Fundus photo taken with a portable handheld camera
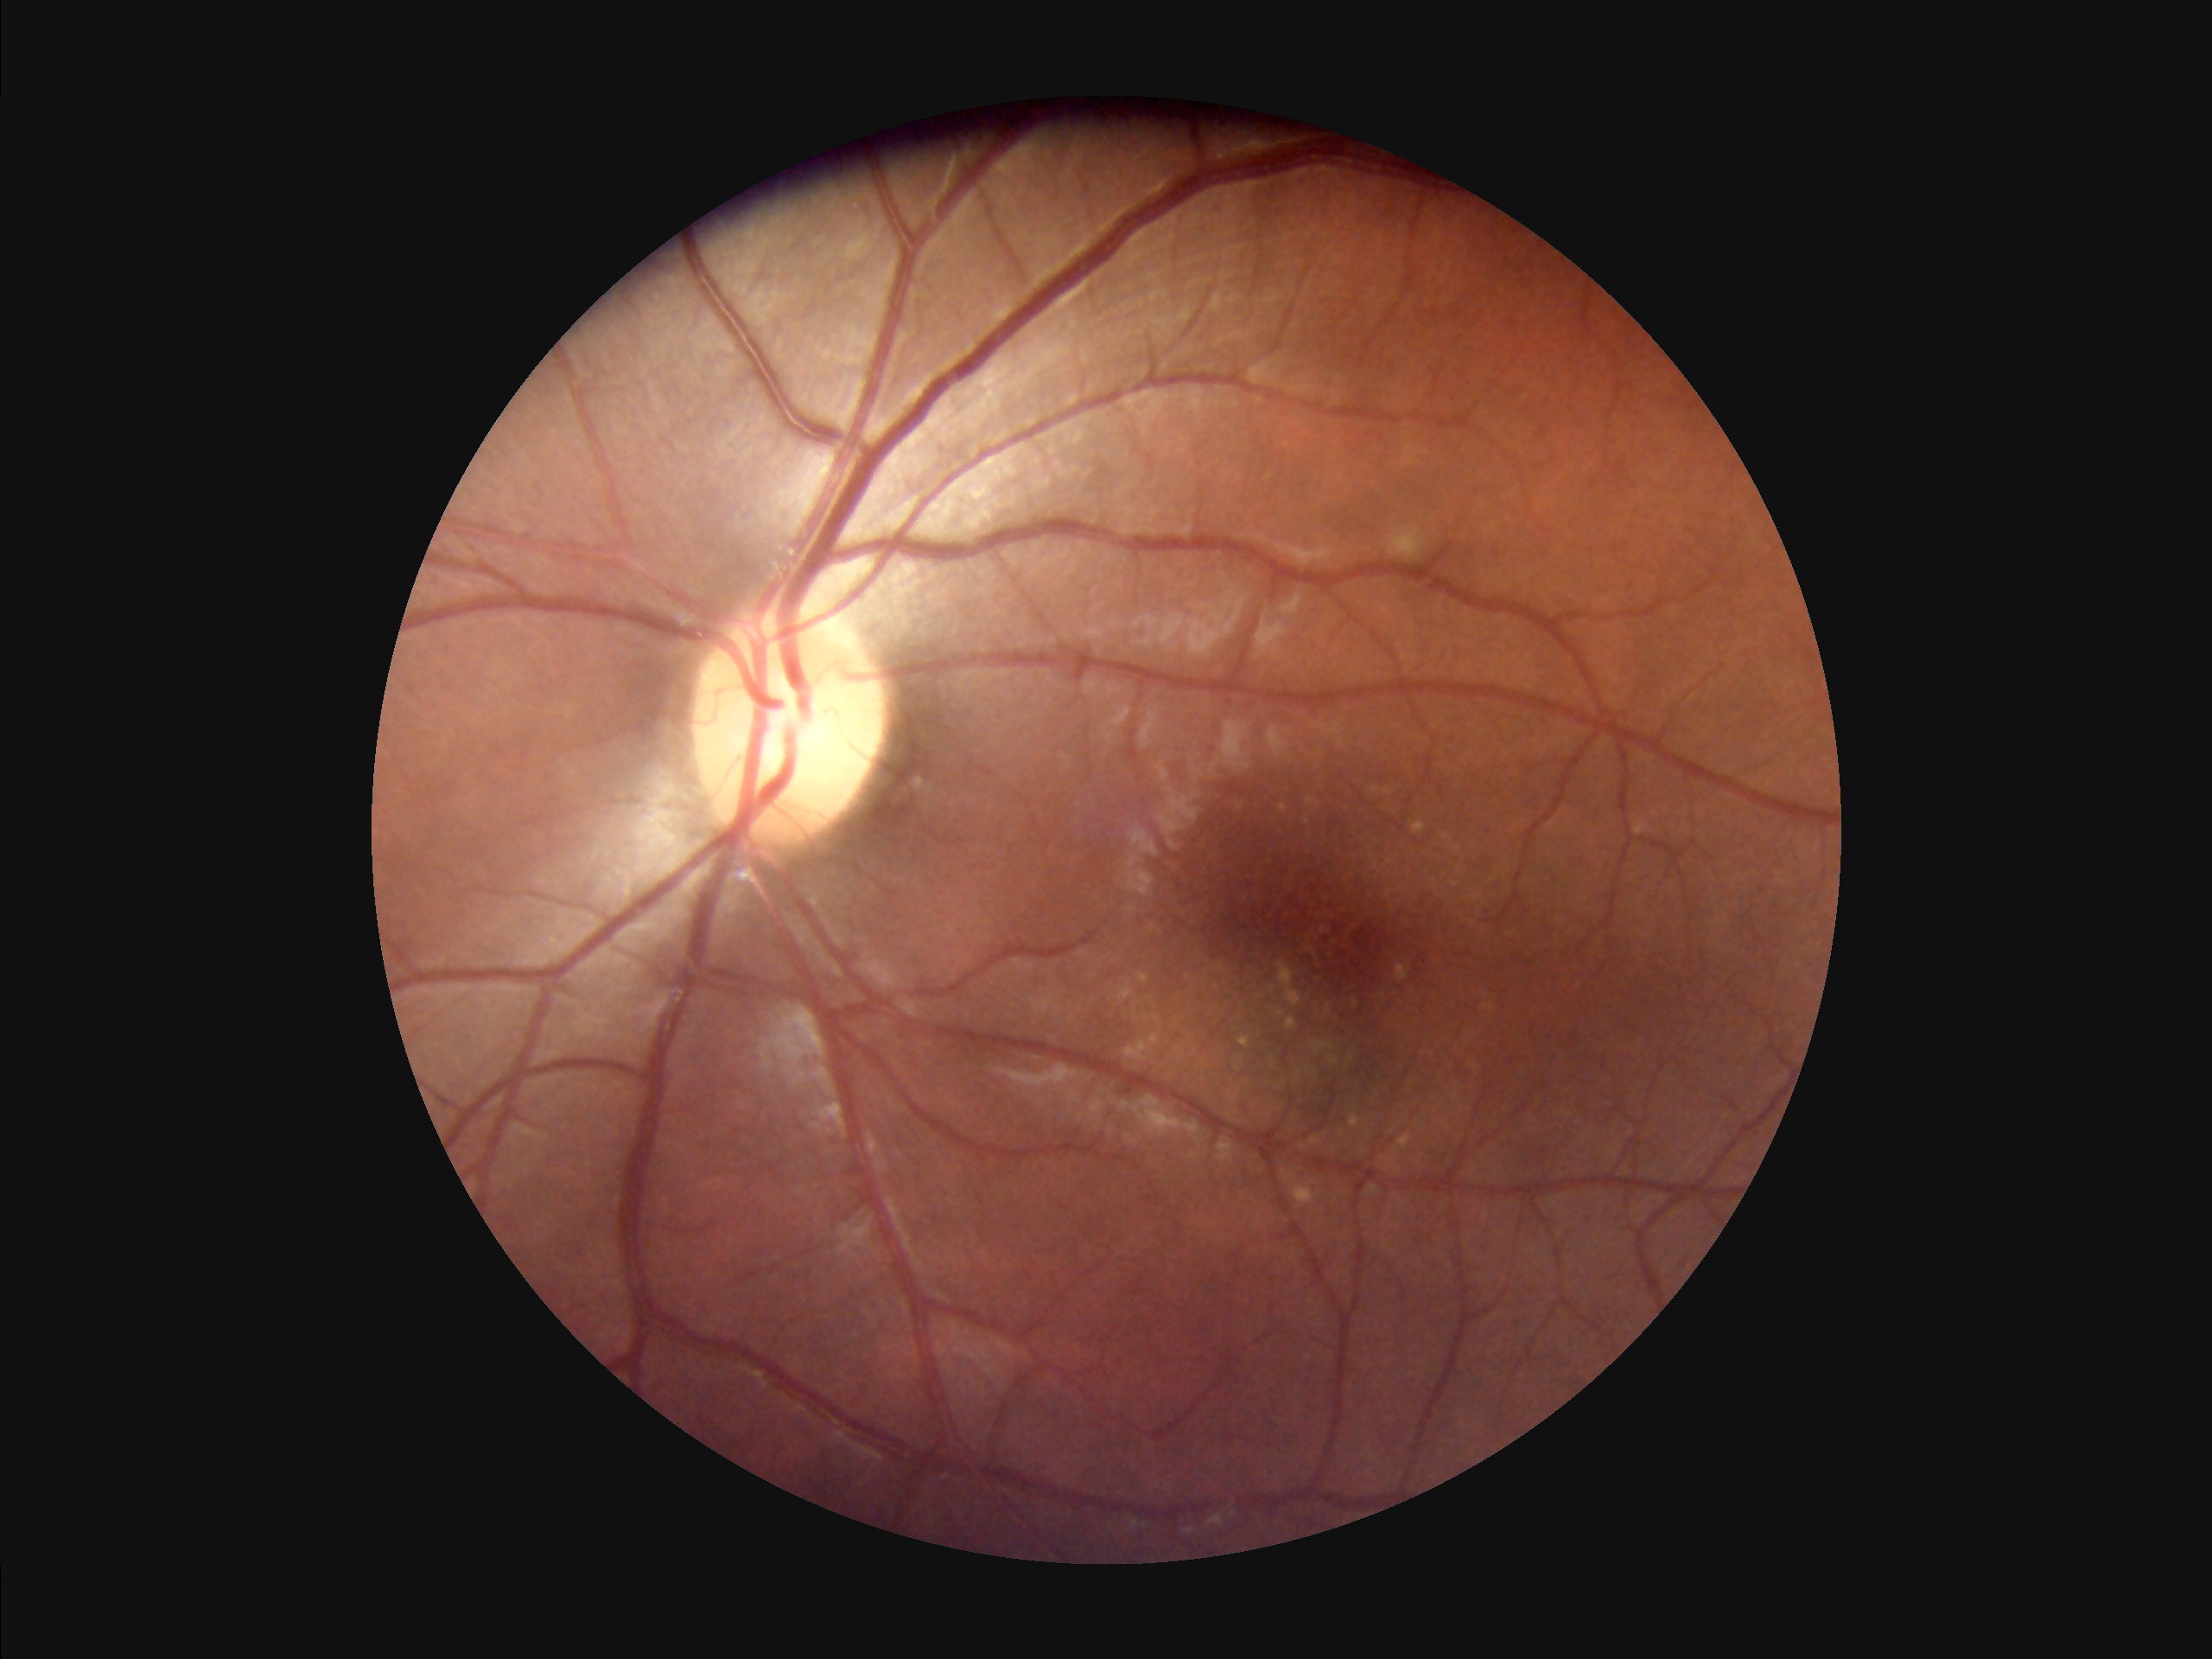 The image is clear. Overall quality is good and the image is gradable. Good dynamic range. Illumination and color balance are good.